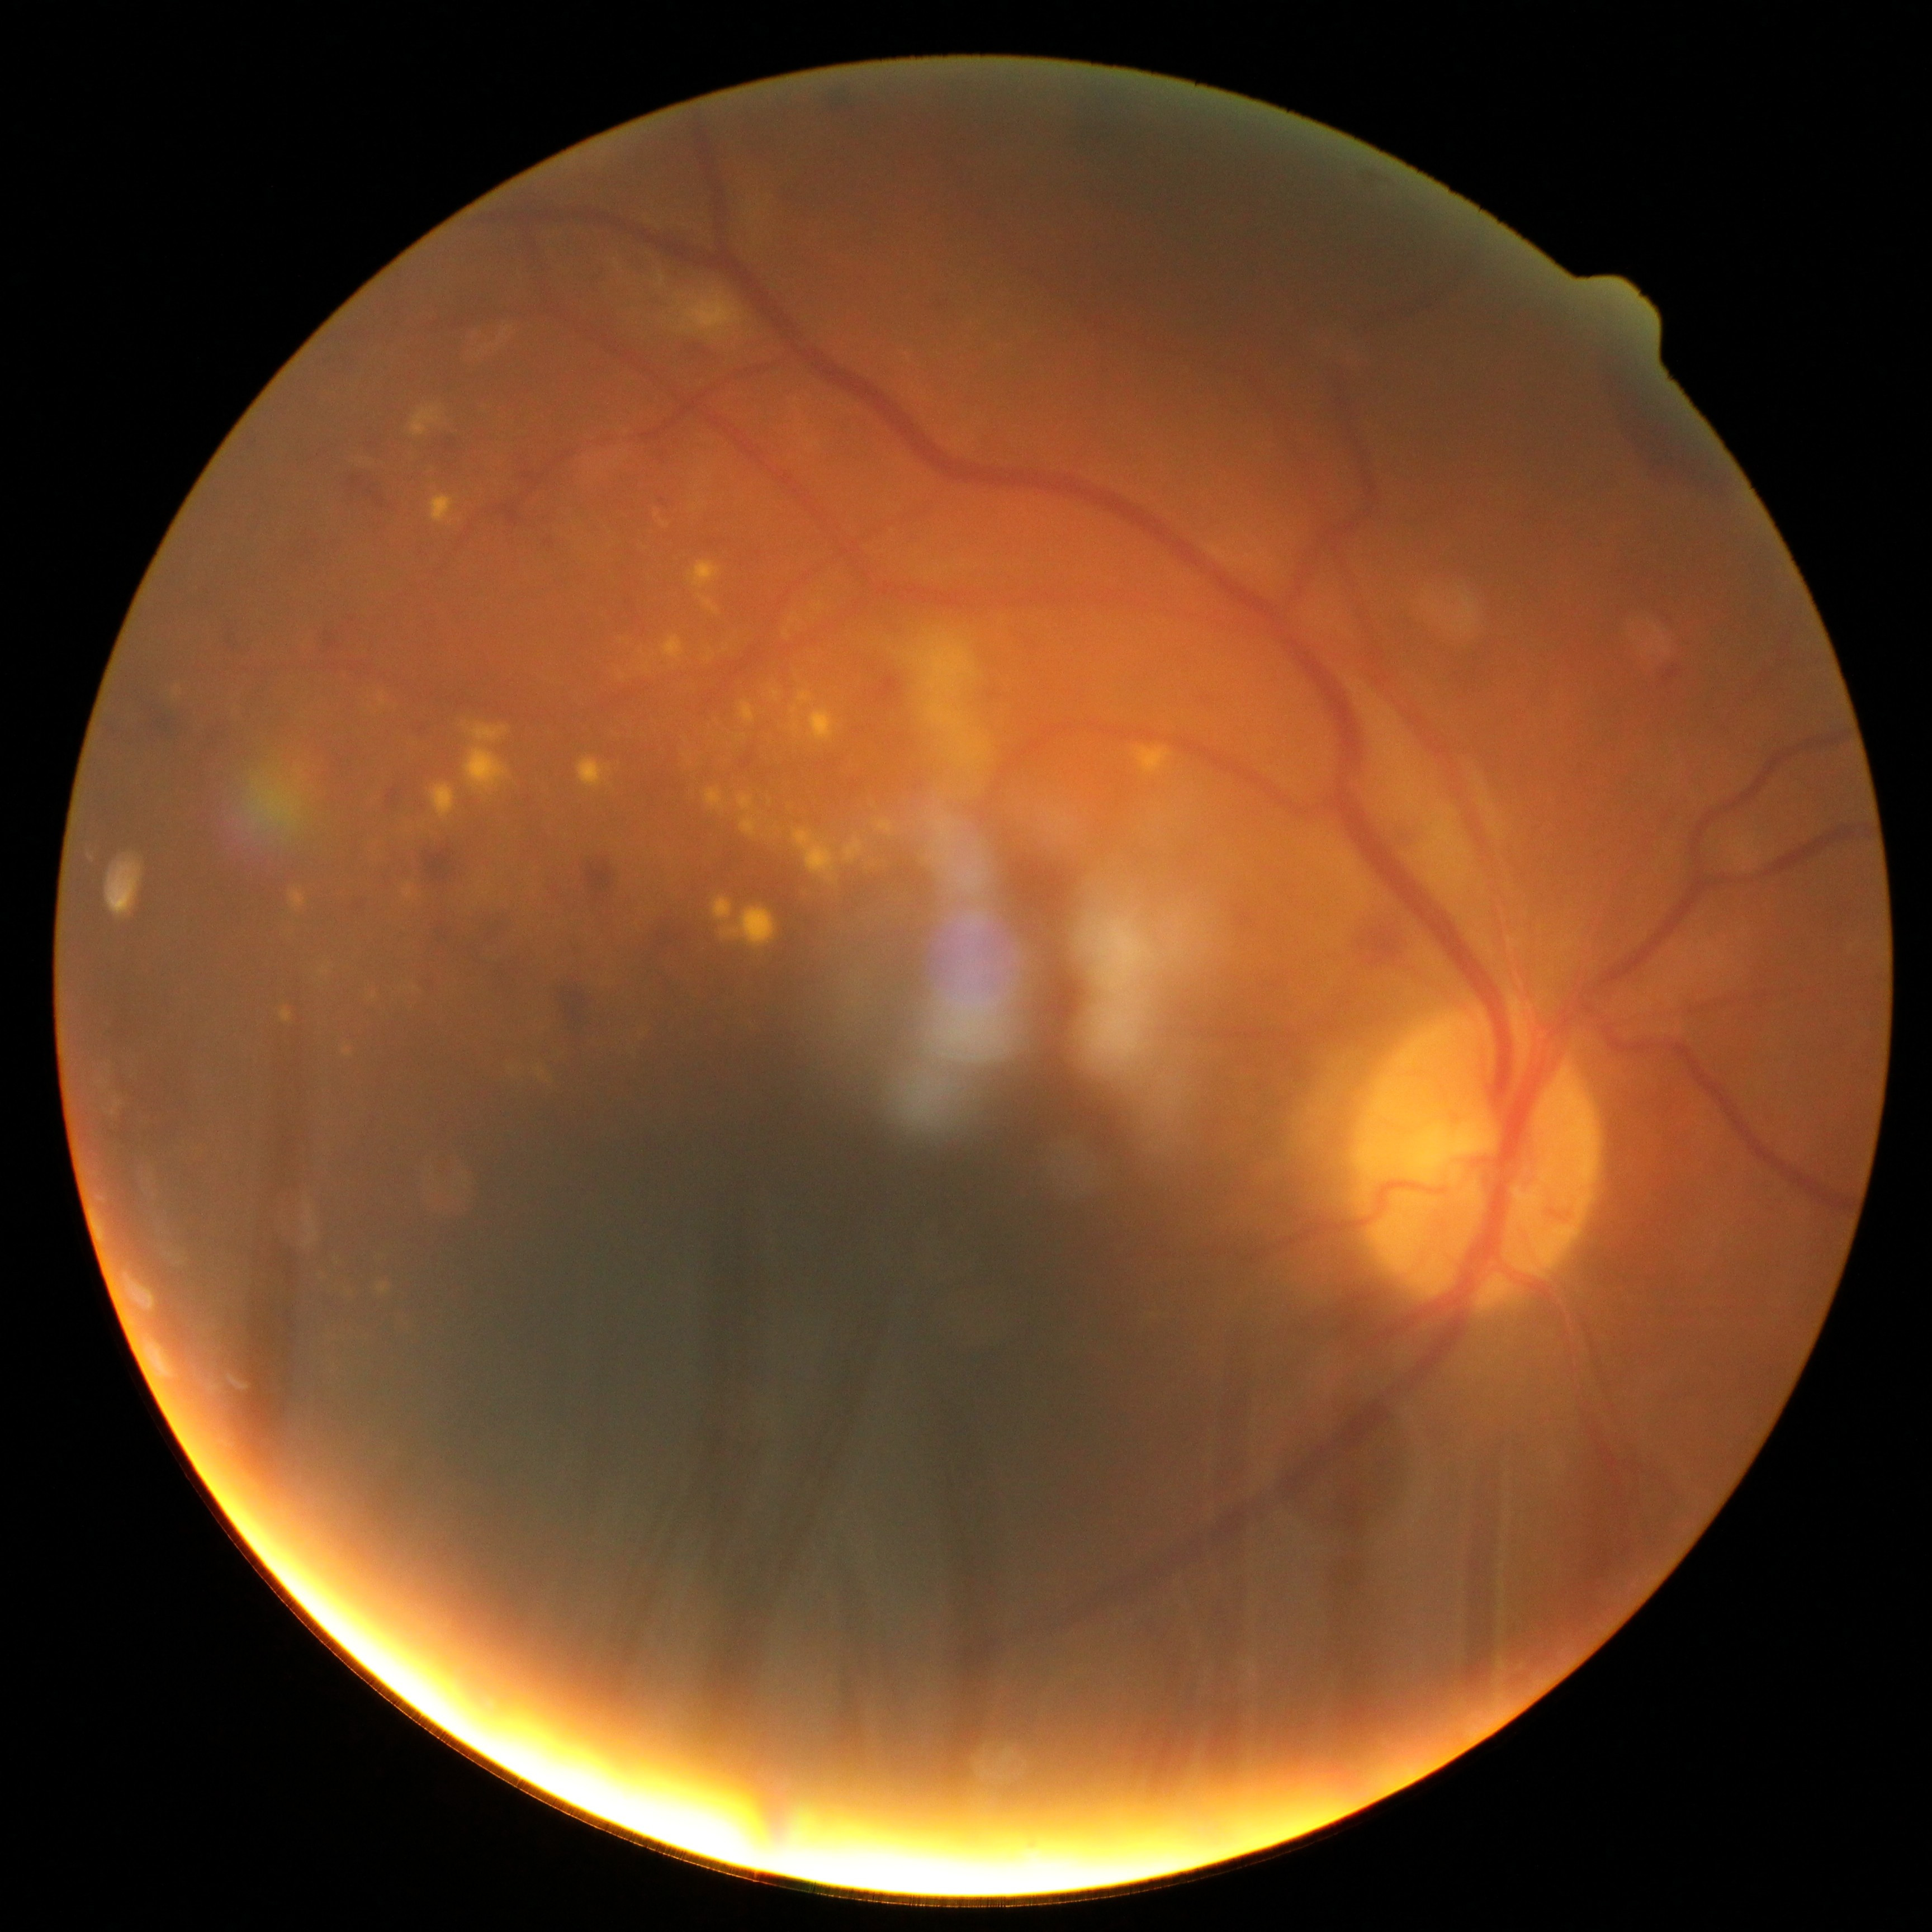 Diabetic retinopathy (DR) is 2/4.